Retinal fundus photograph. FOV: 45 degrees: 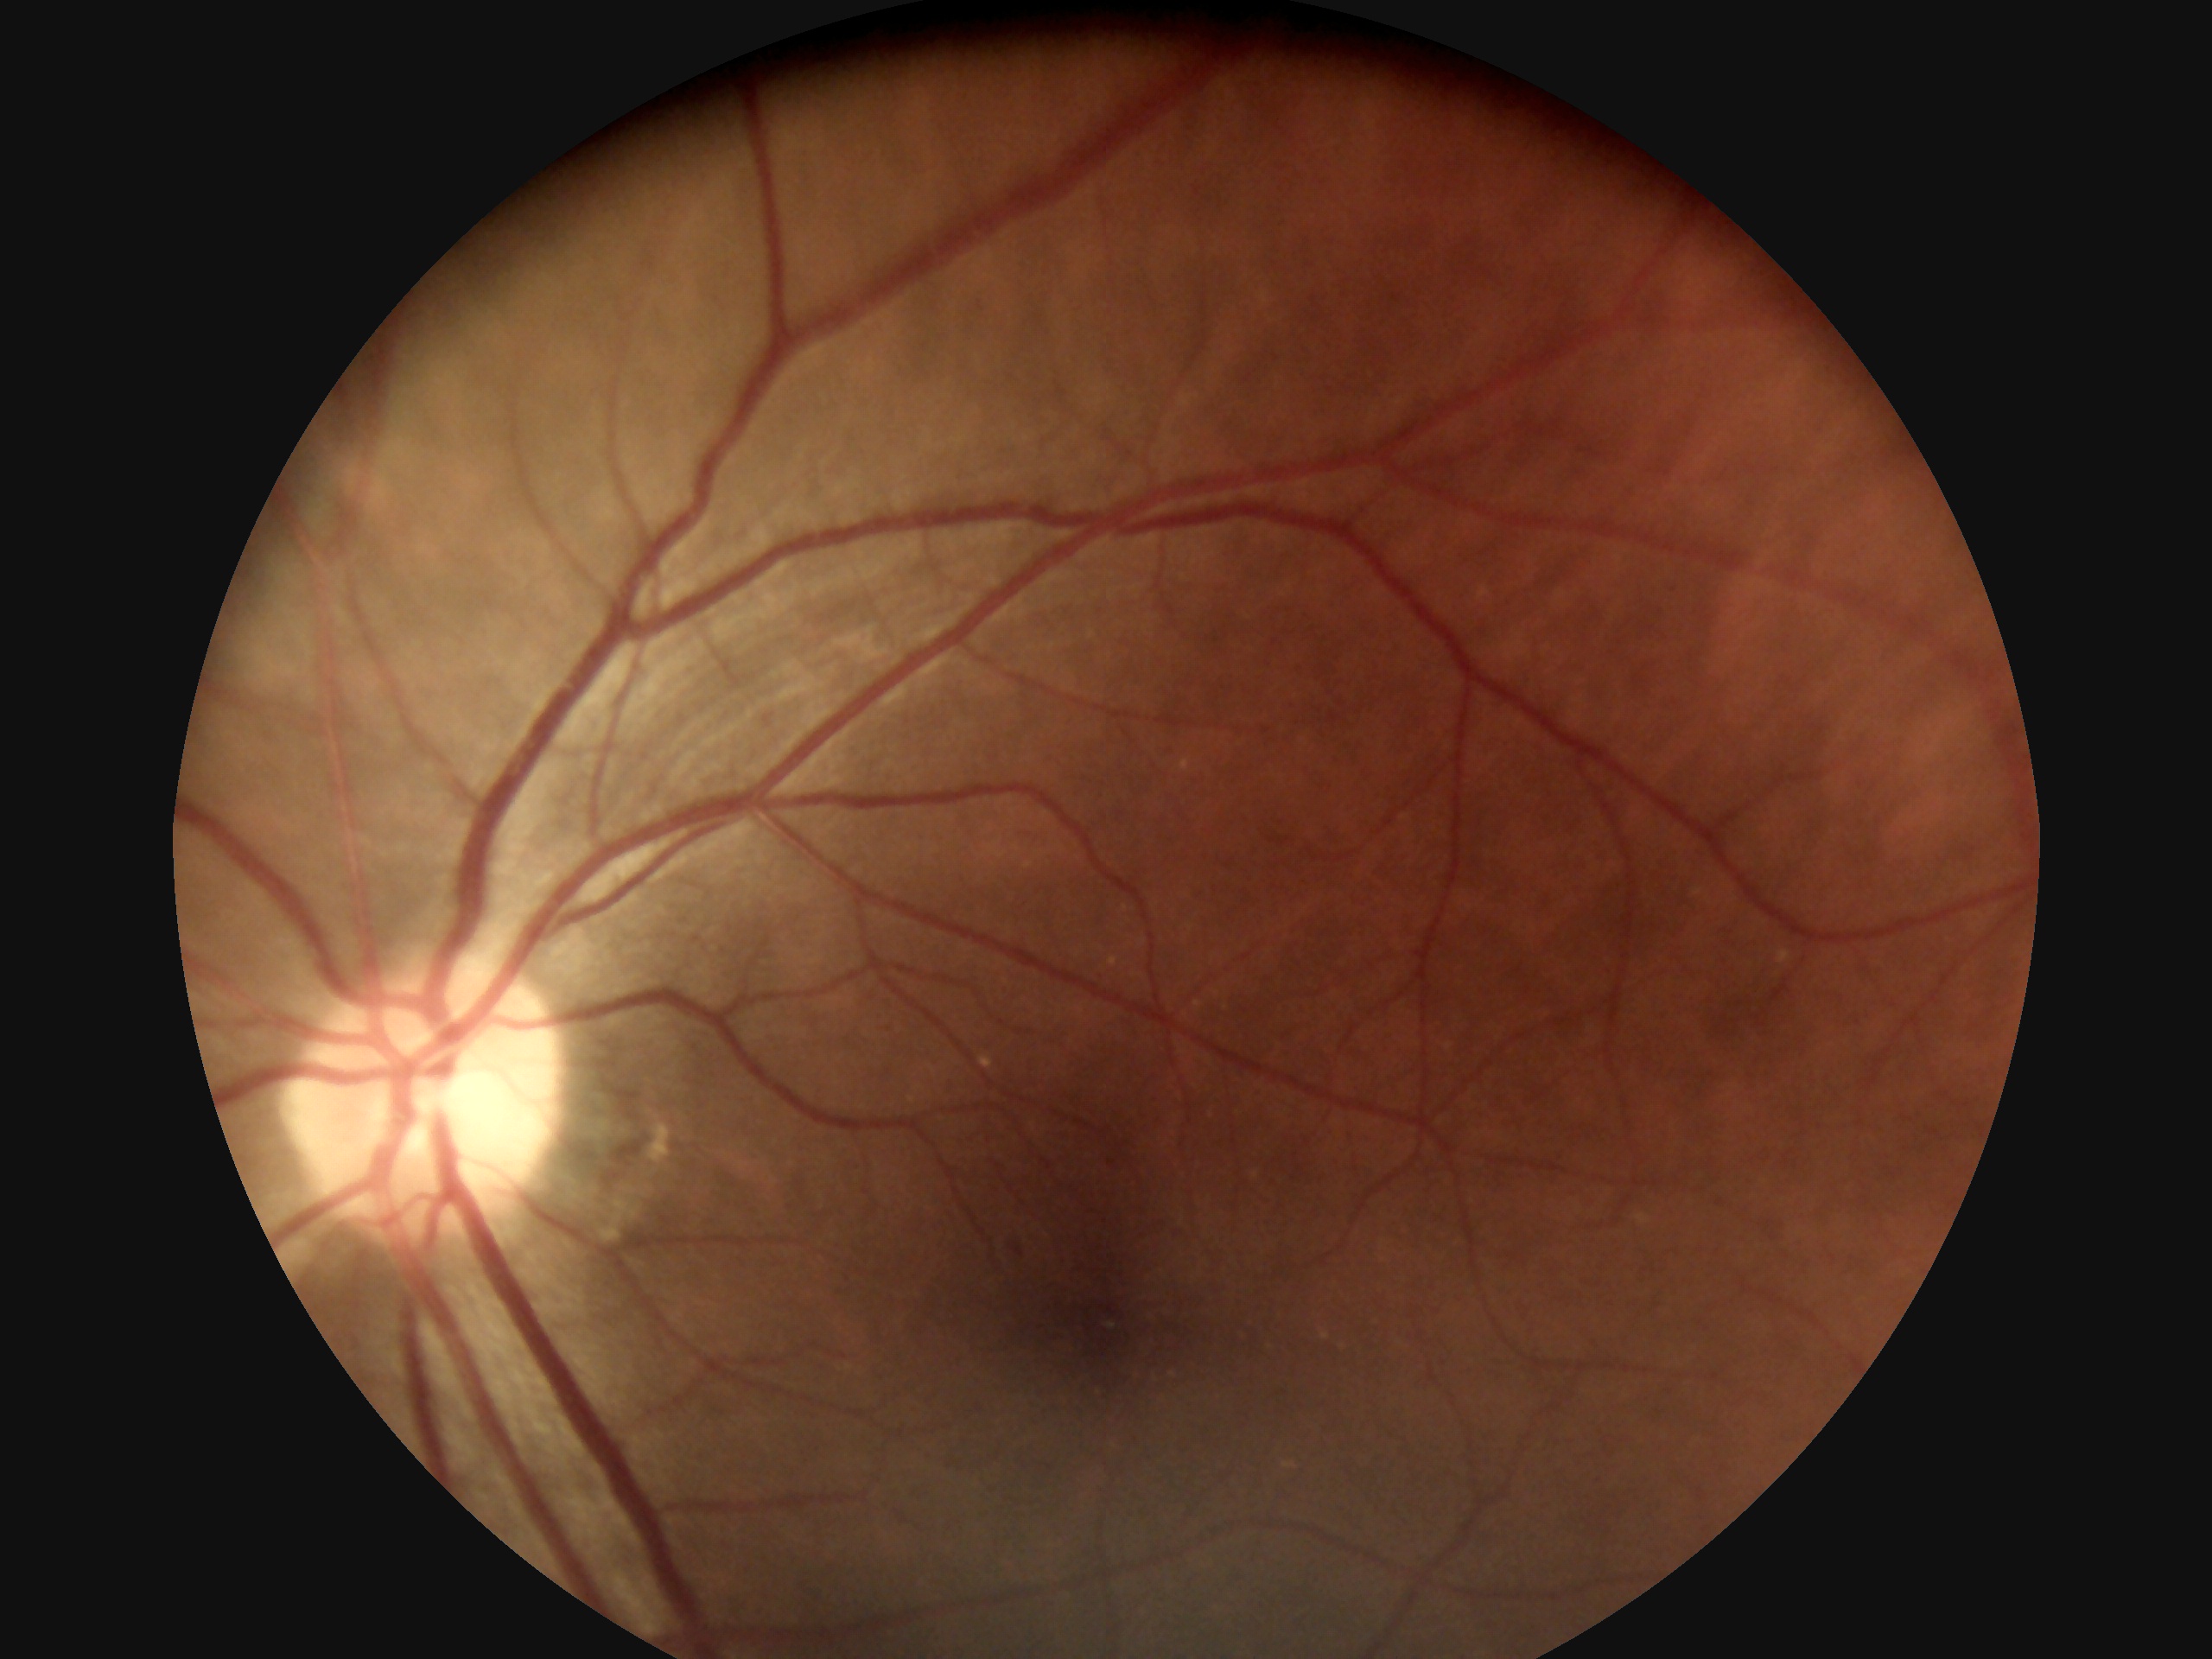

Diabetic retinopathy (DR): mild non-proliferative diabetic retinopathy (grade 1).